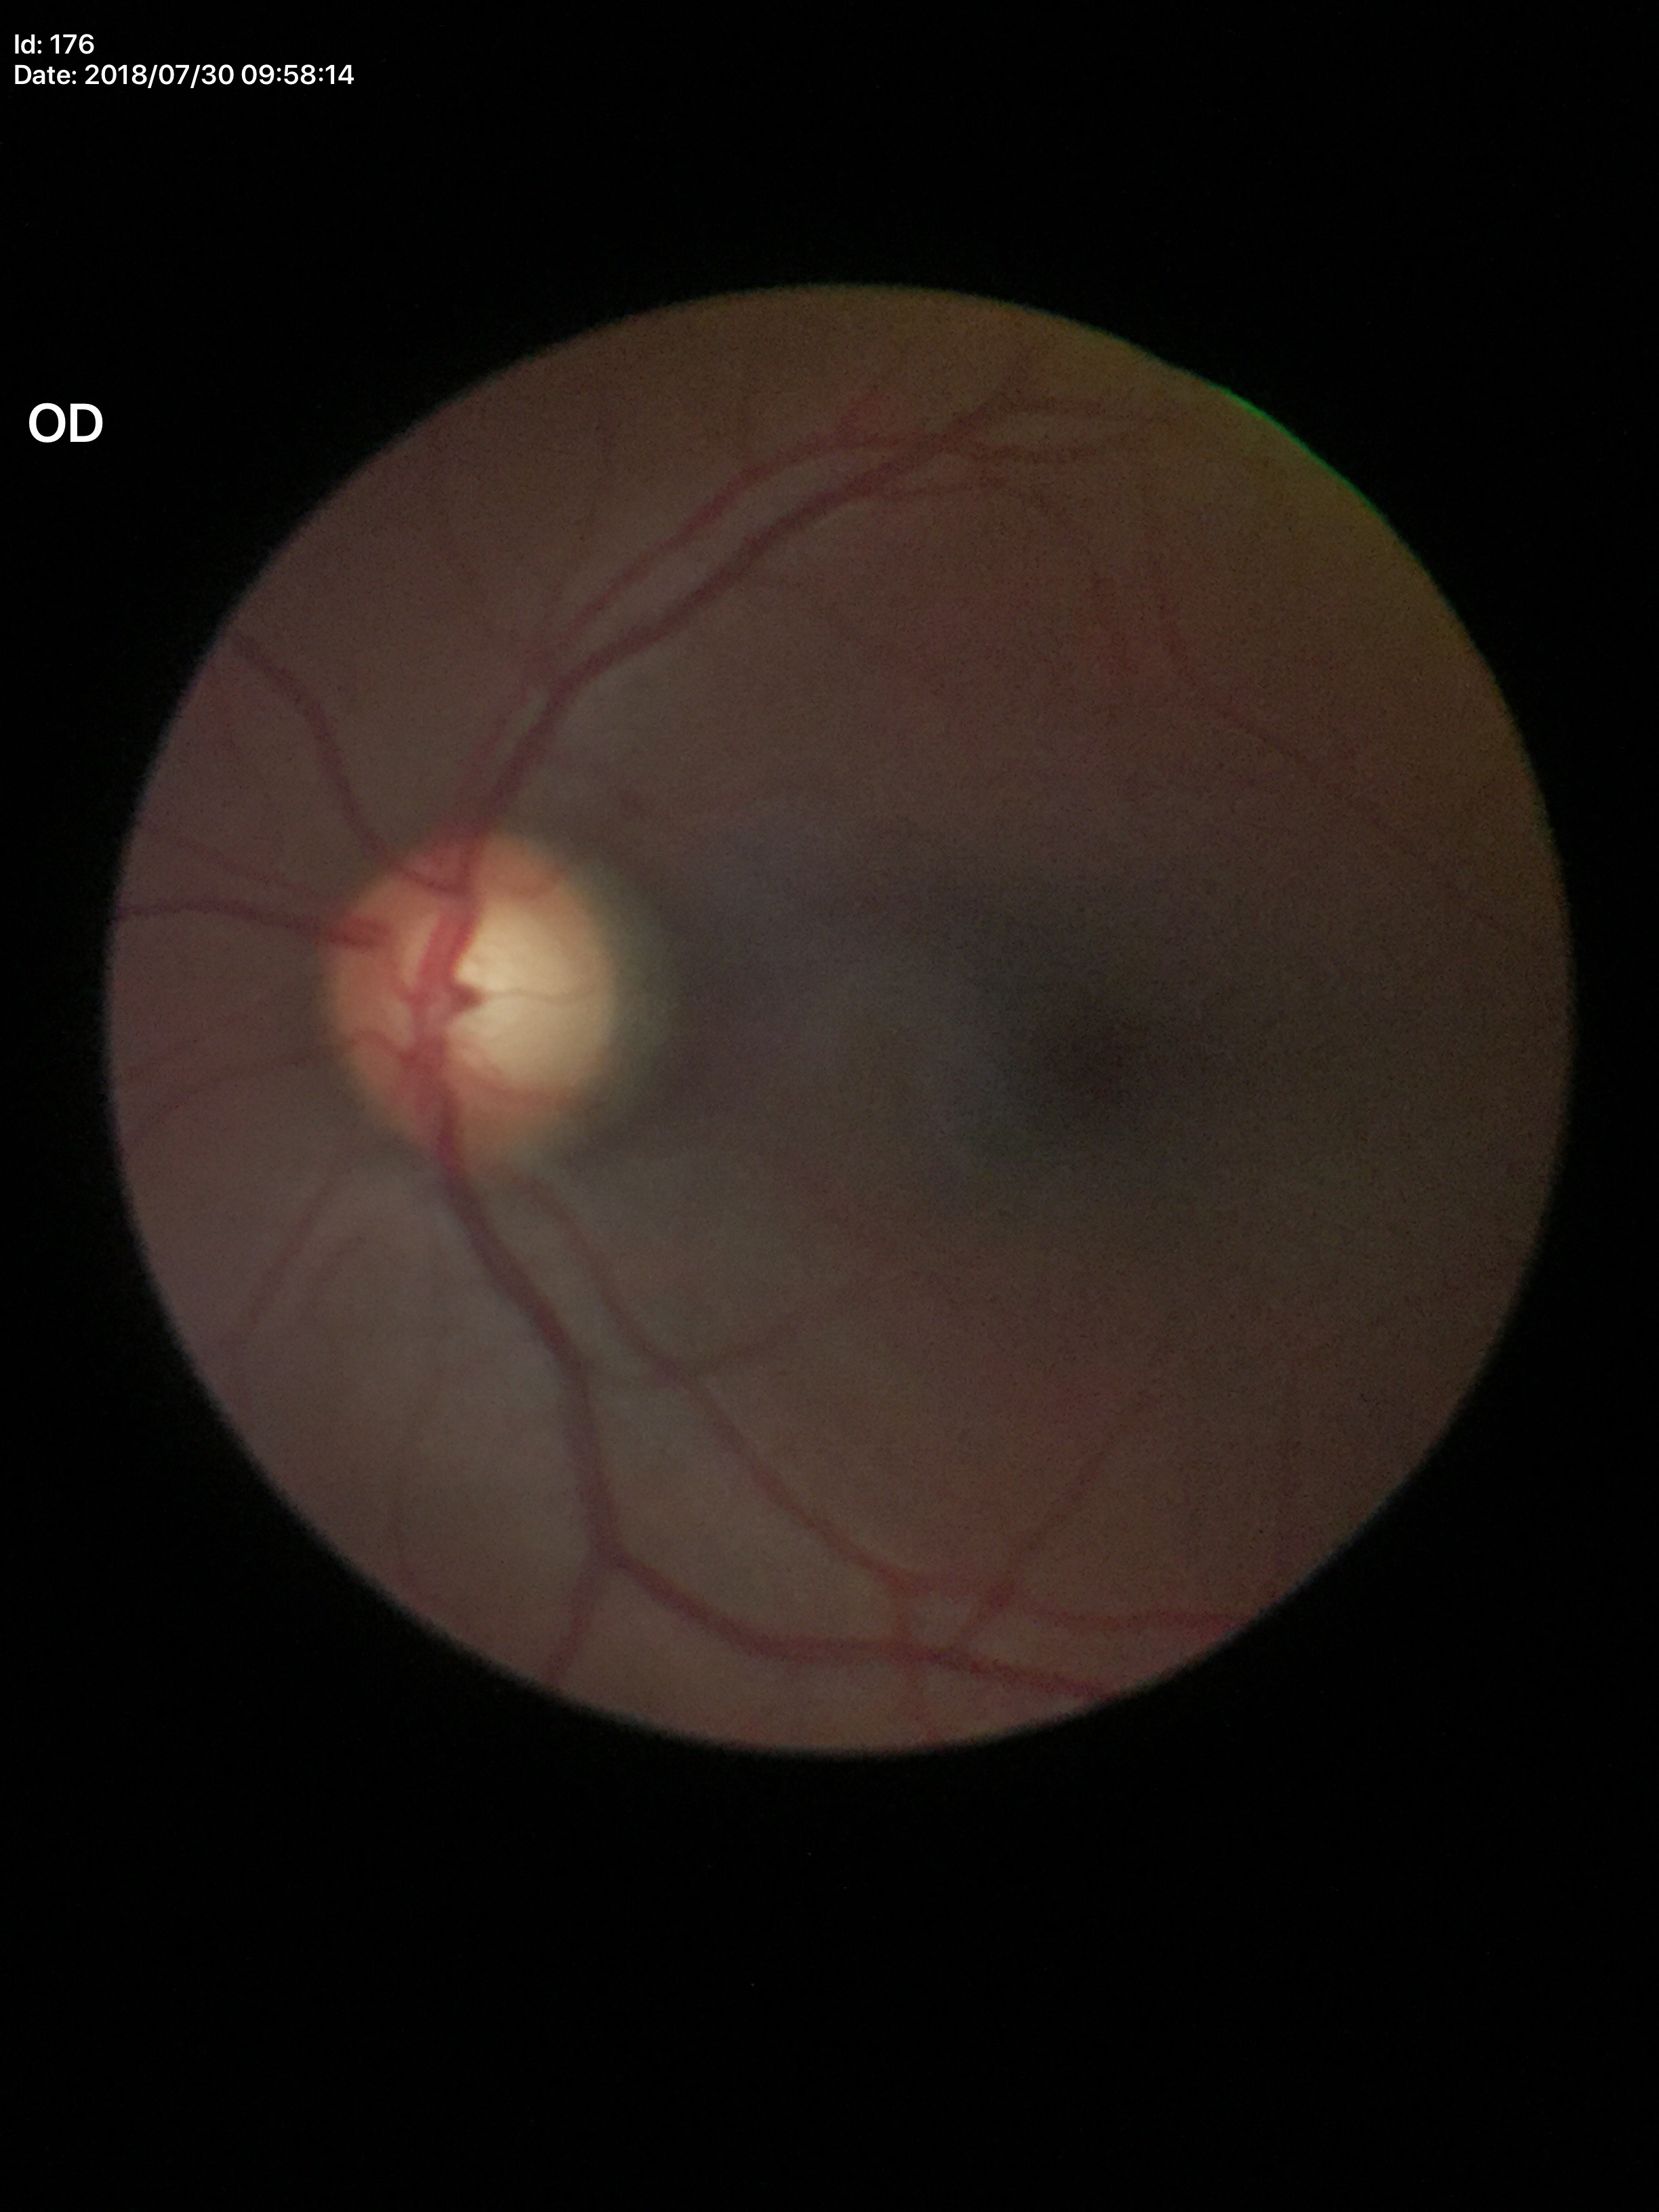

Horizontal CDR of 0.66. Concerning for glaucoma. Vertical cup-to-disc ratio of 0.65.